DR severity per modified Davis staging
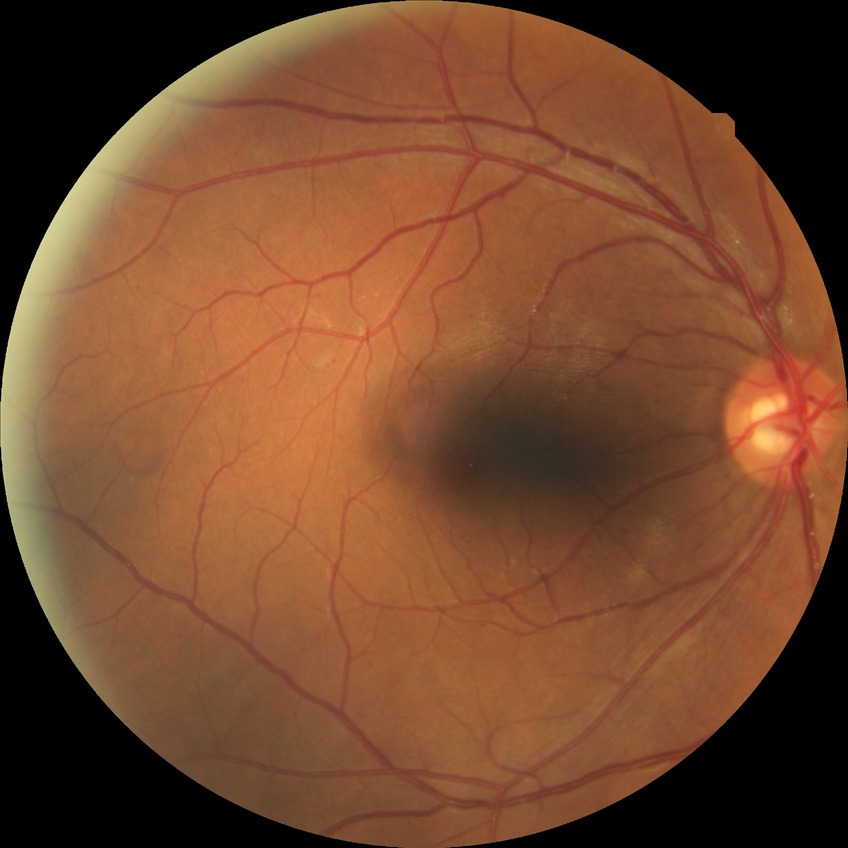 retinopathy grade: simple diabetic retinopathy